NIDEK AFC-230 fundus camera; graded on the modified Davis scale; FOV: 45 degrees: 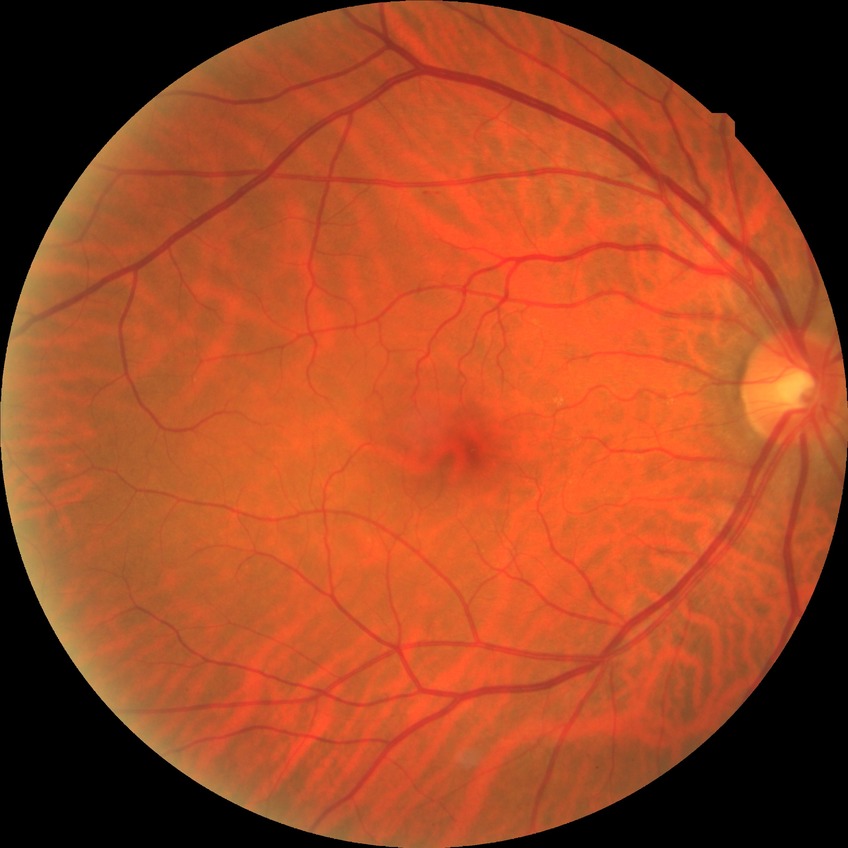
Diabetic retinopathy (DR): no diabetic retinopathy (NDR).